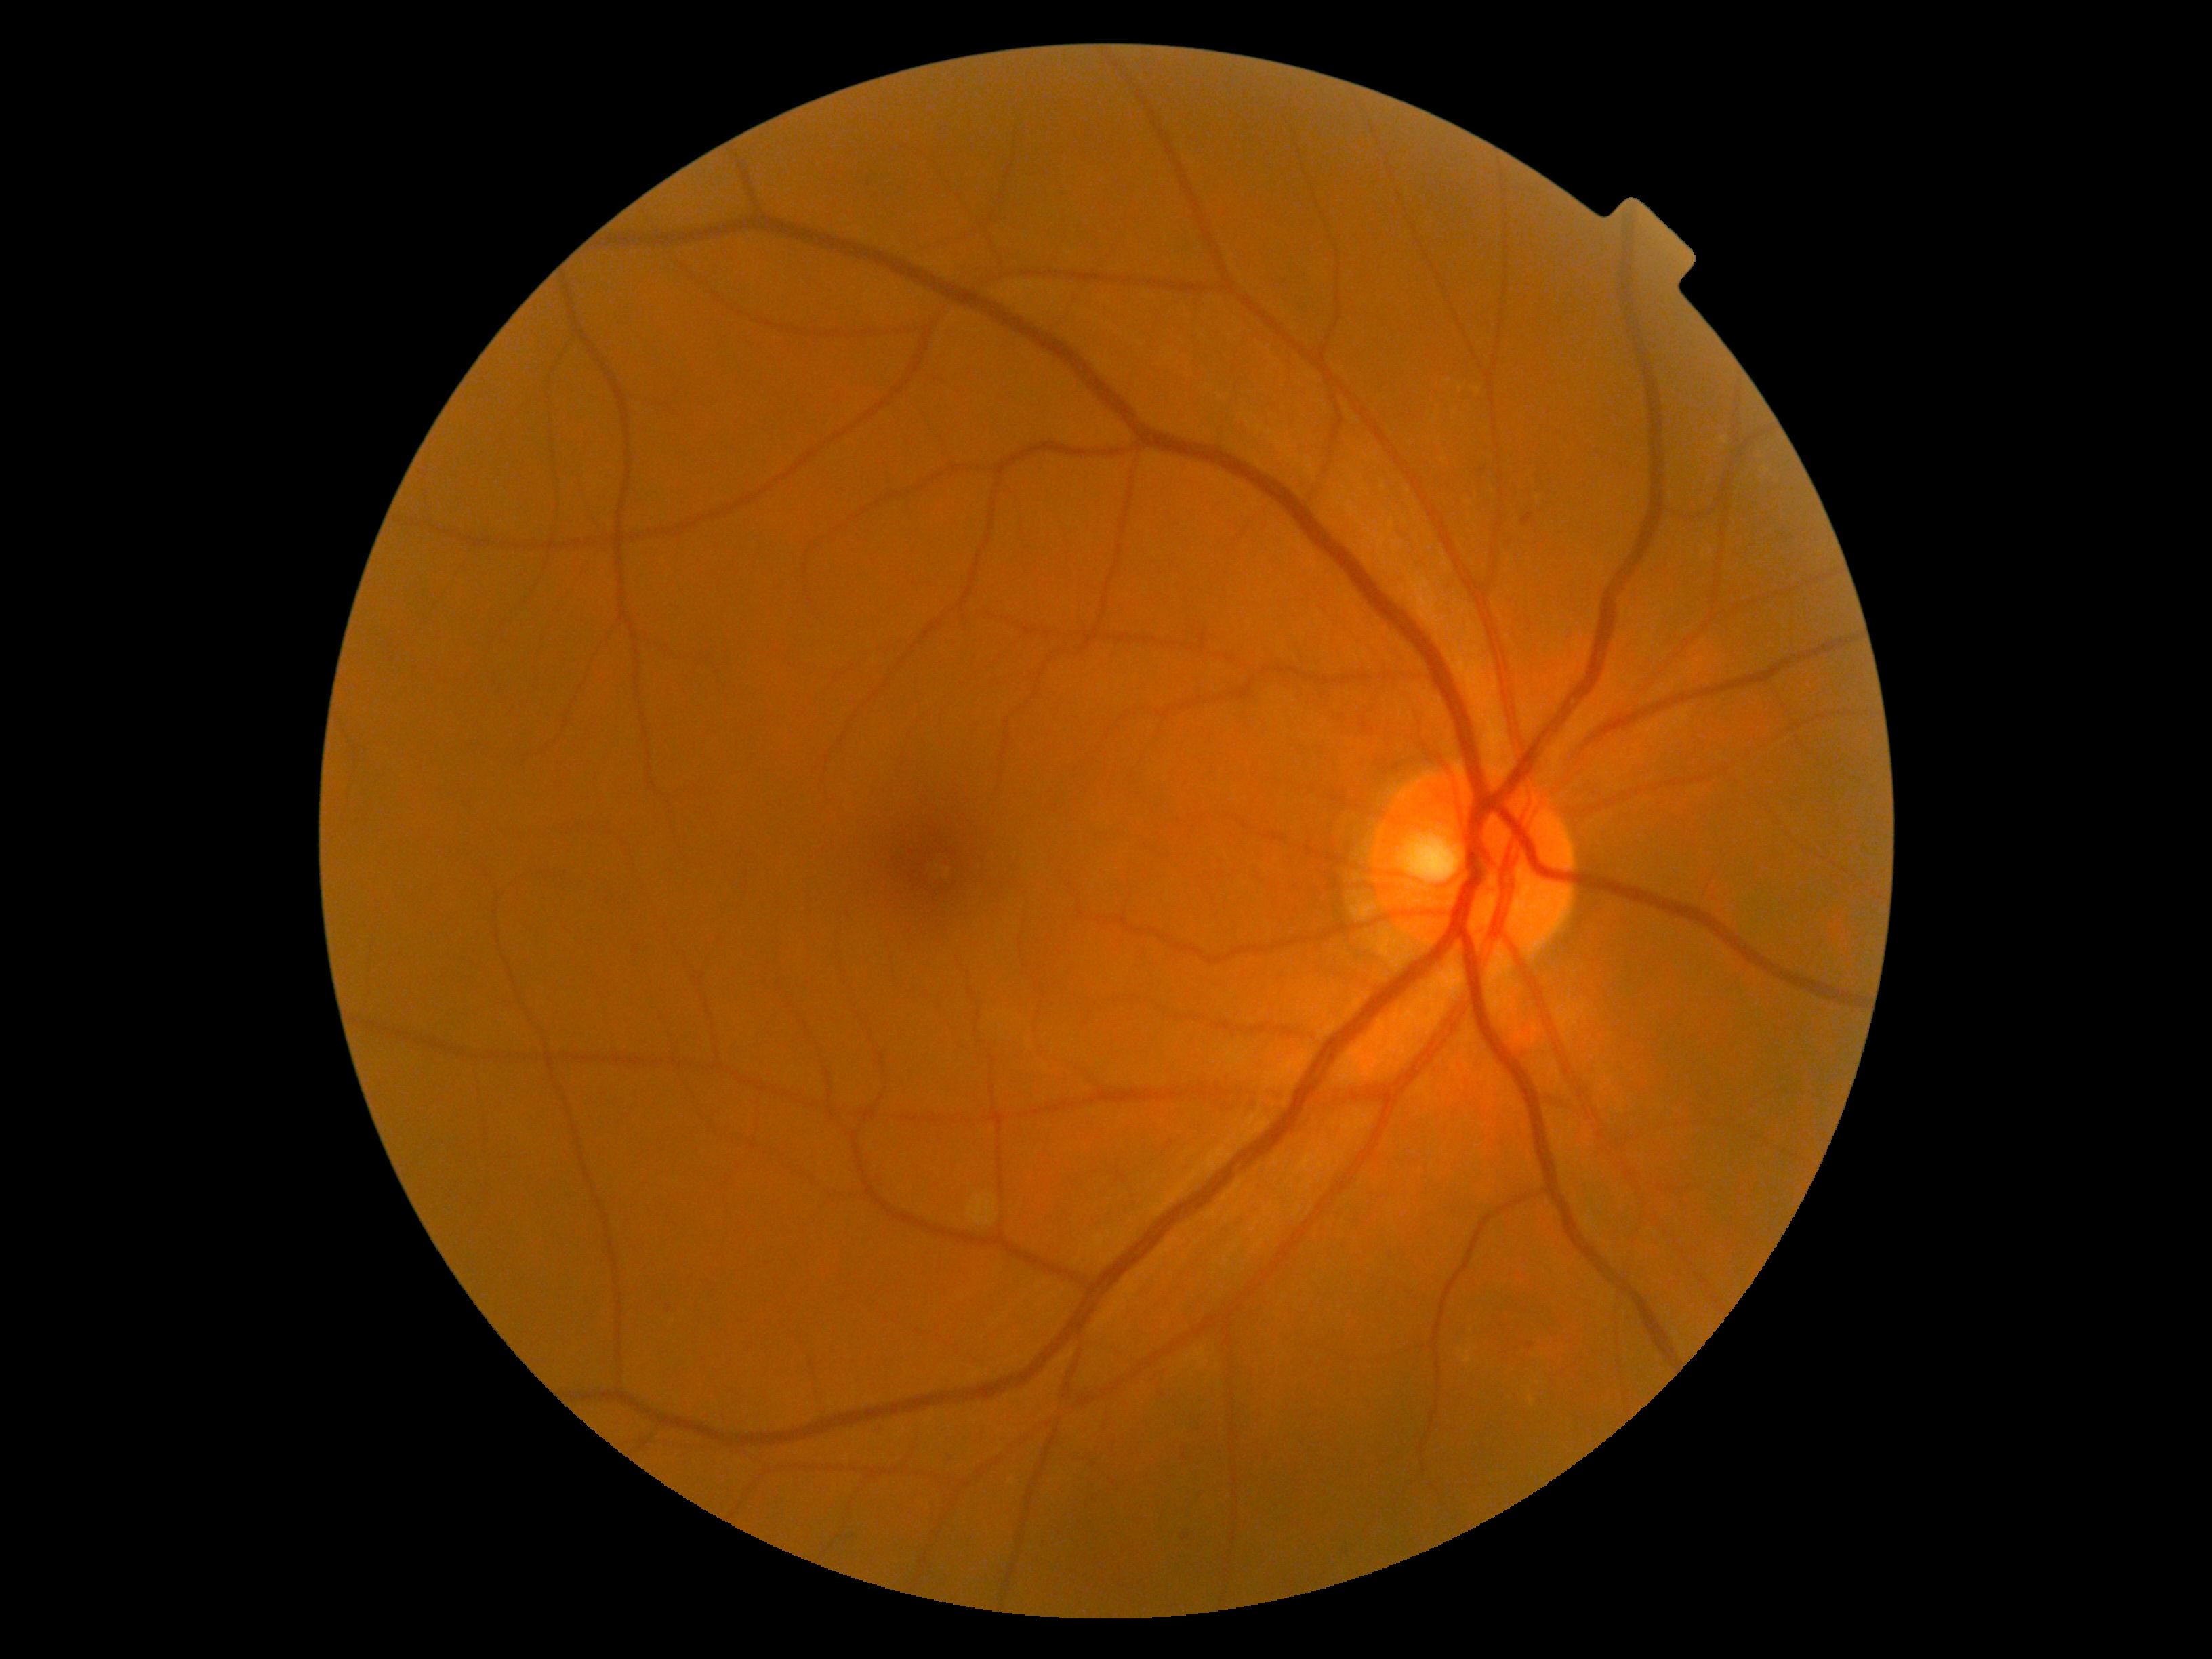

DR = moderate non-proliferative diabetic retinopathy (grade 2).